Diabetic retinopathy graded by the modified Davis classification:
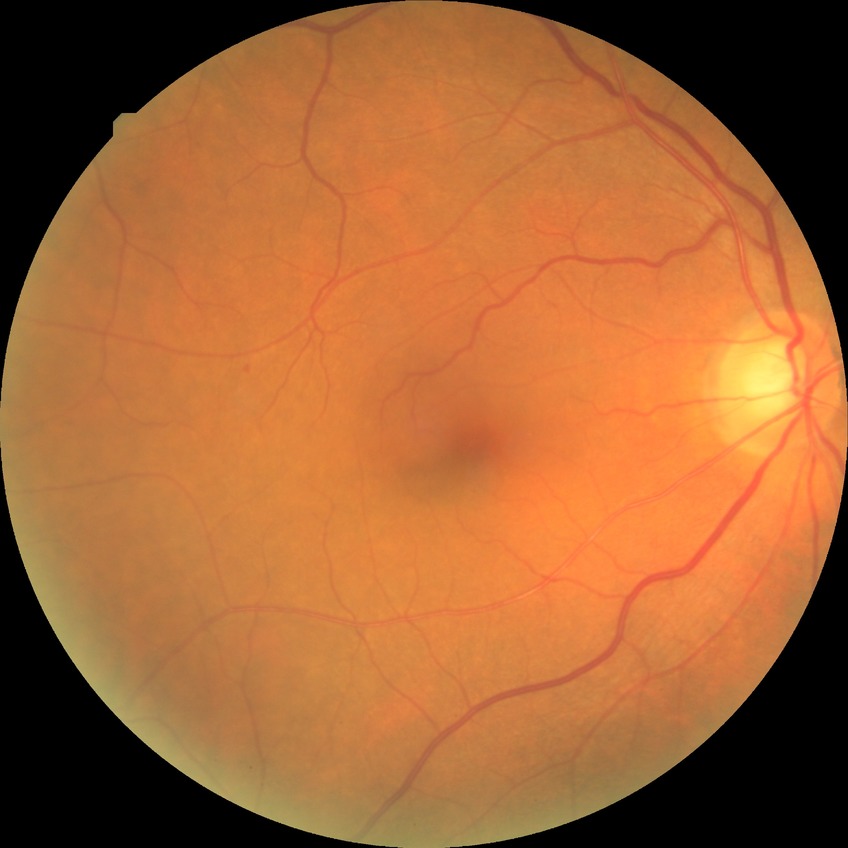 Modified Davis grading is simple diabetic retinopathy.